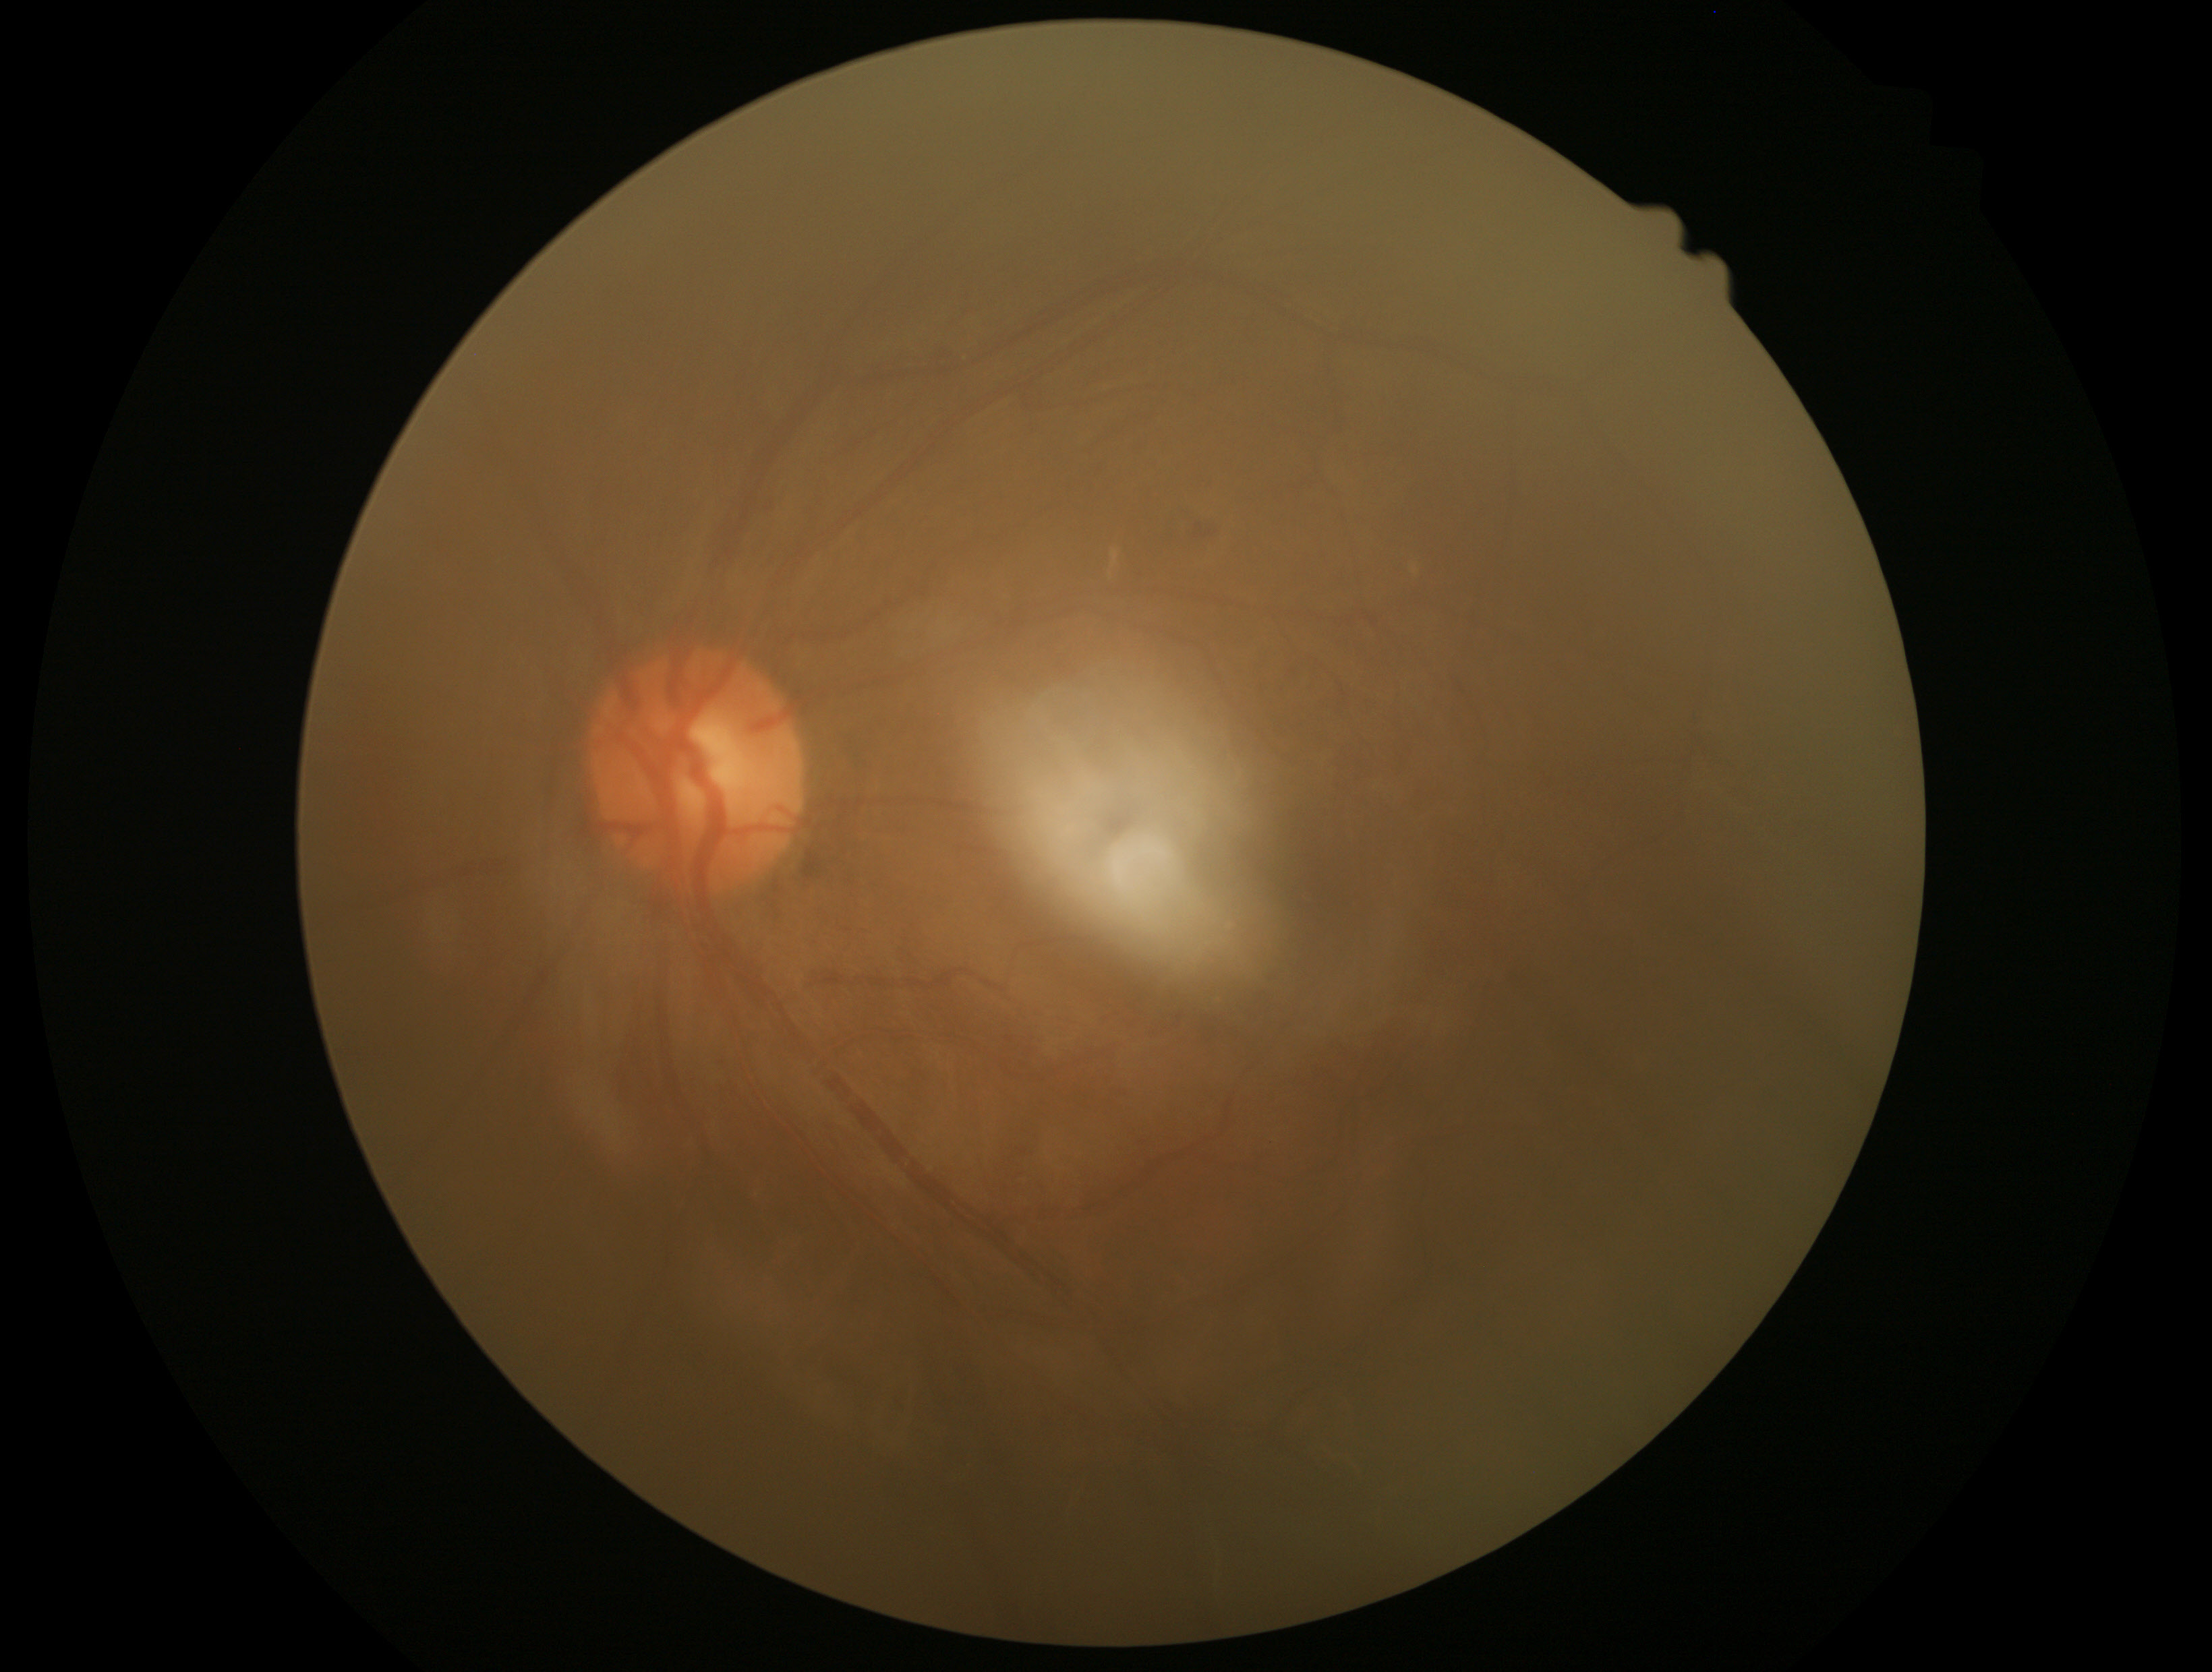

DR severity: moderate NPDR (grade 2).